DR severity per modified Davis staging; posterior pole color fundus photograph
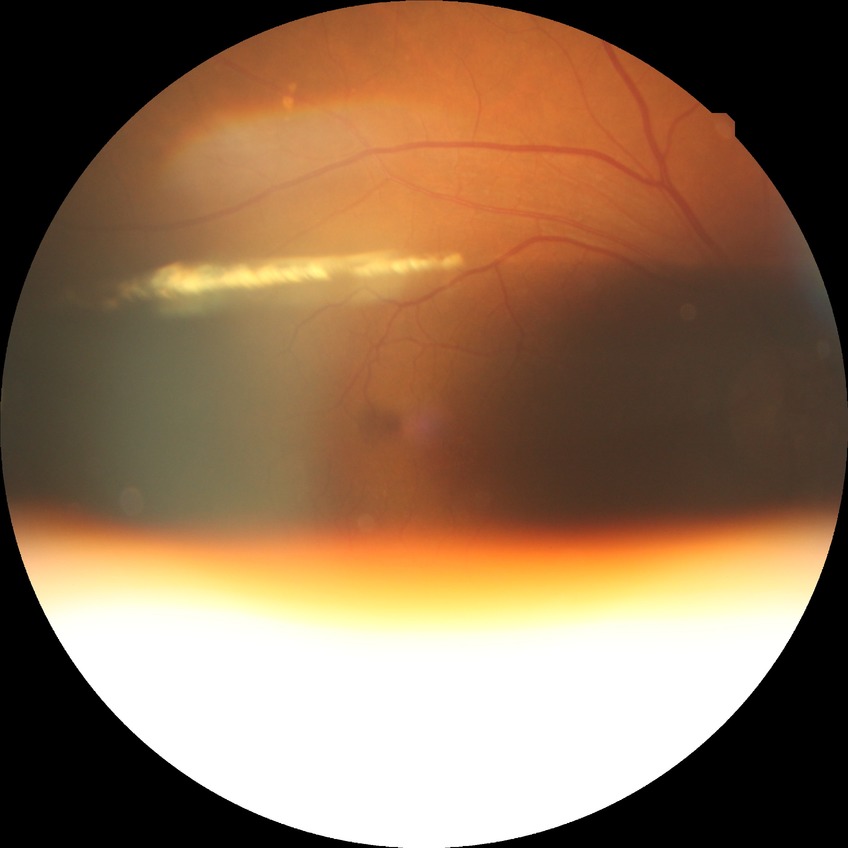

Davis grading is no diabetic retinopathy.